2228x1652px
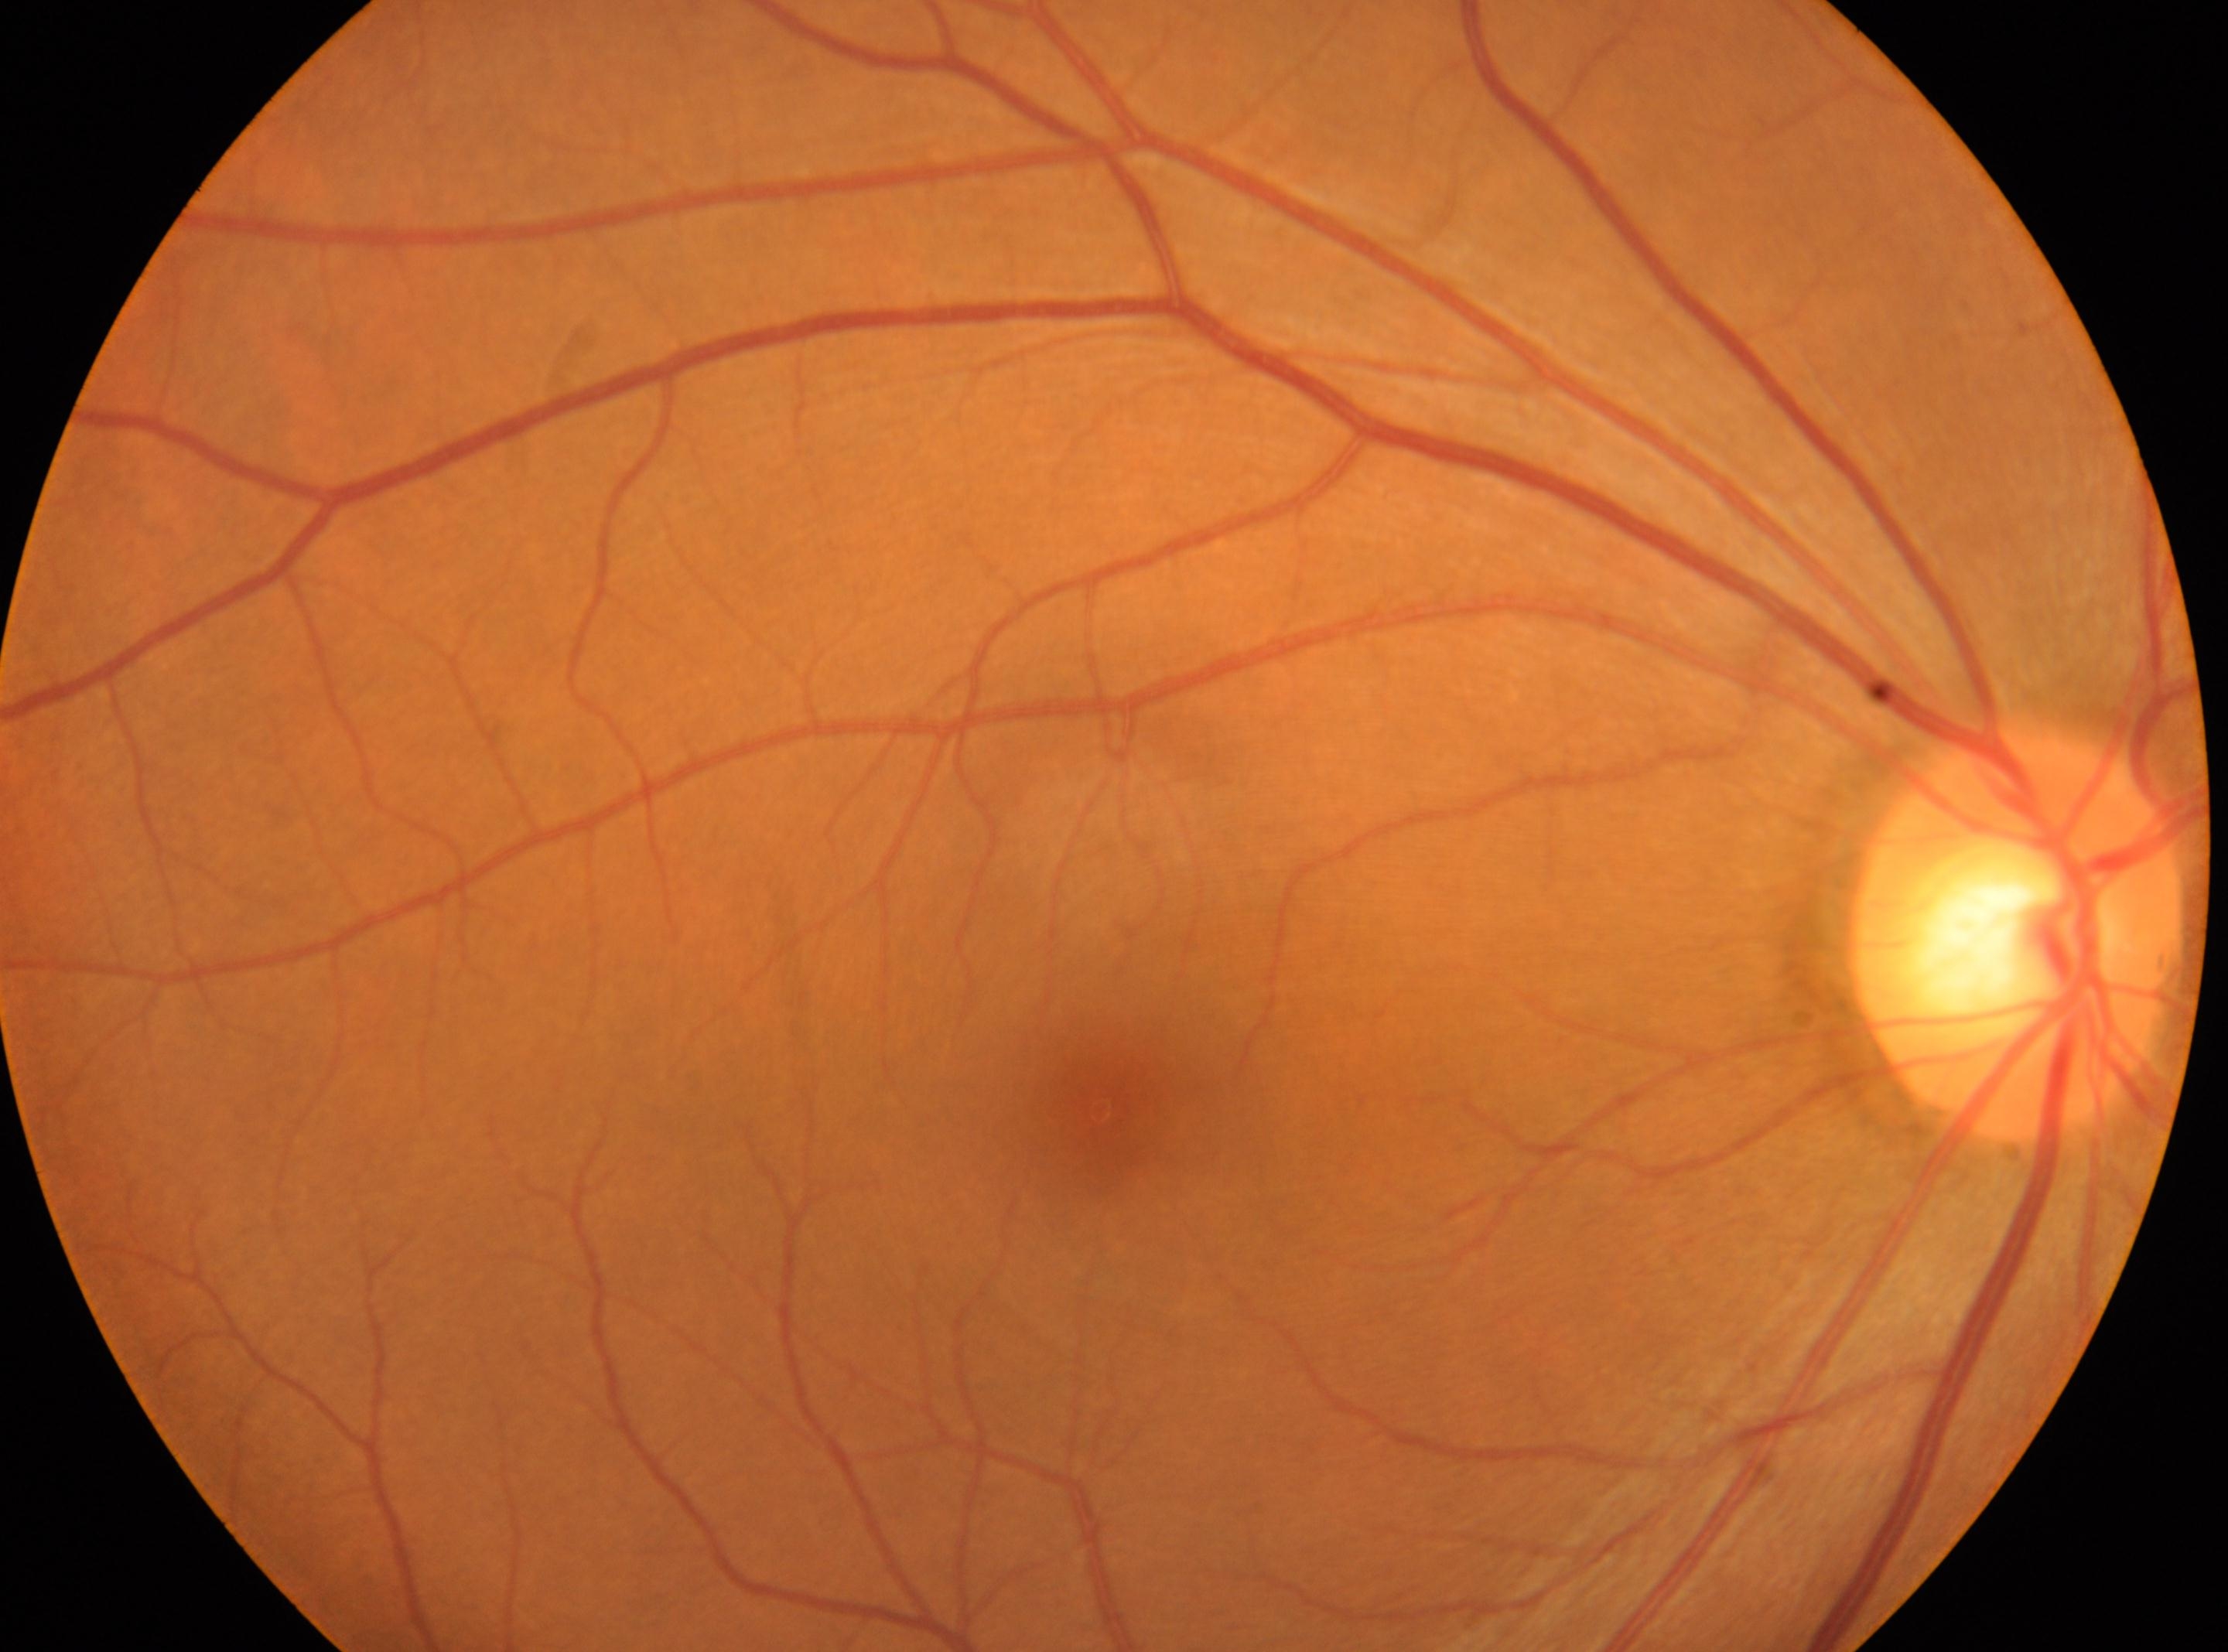
ONH: [2014, 934].
The image shows the right eye.
Macula center: [1100, 1109].
DR severity is 0.